Image size 1970x1876; CFP.
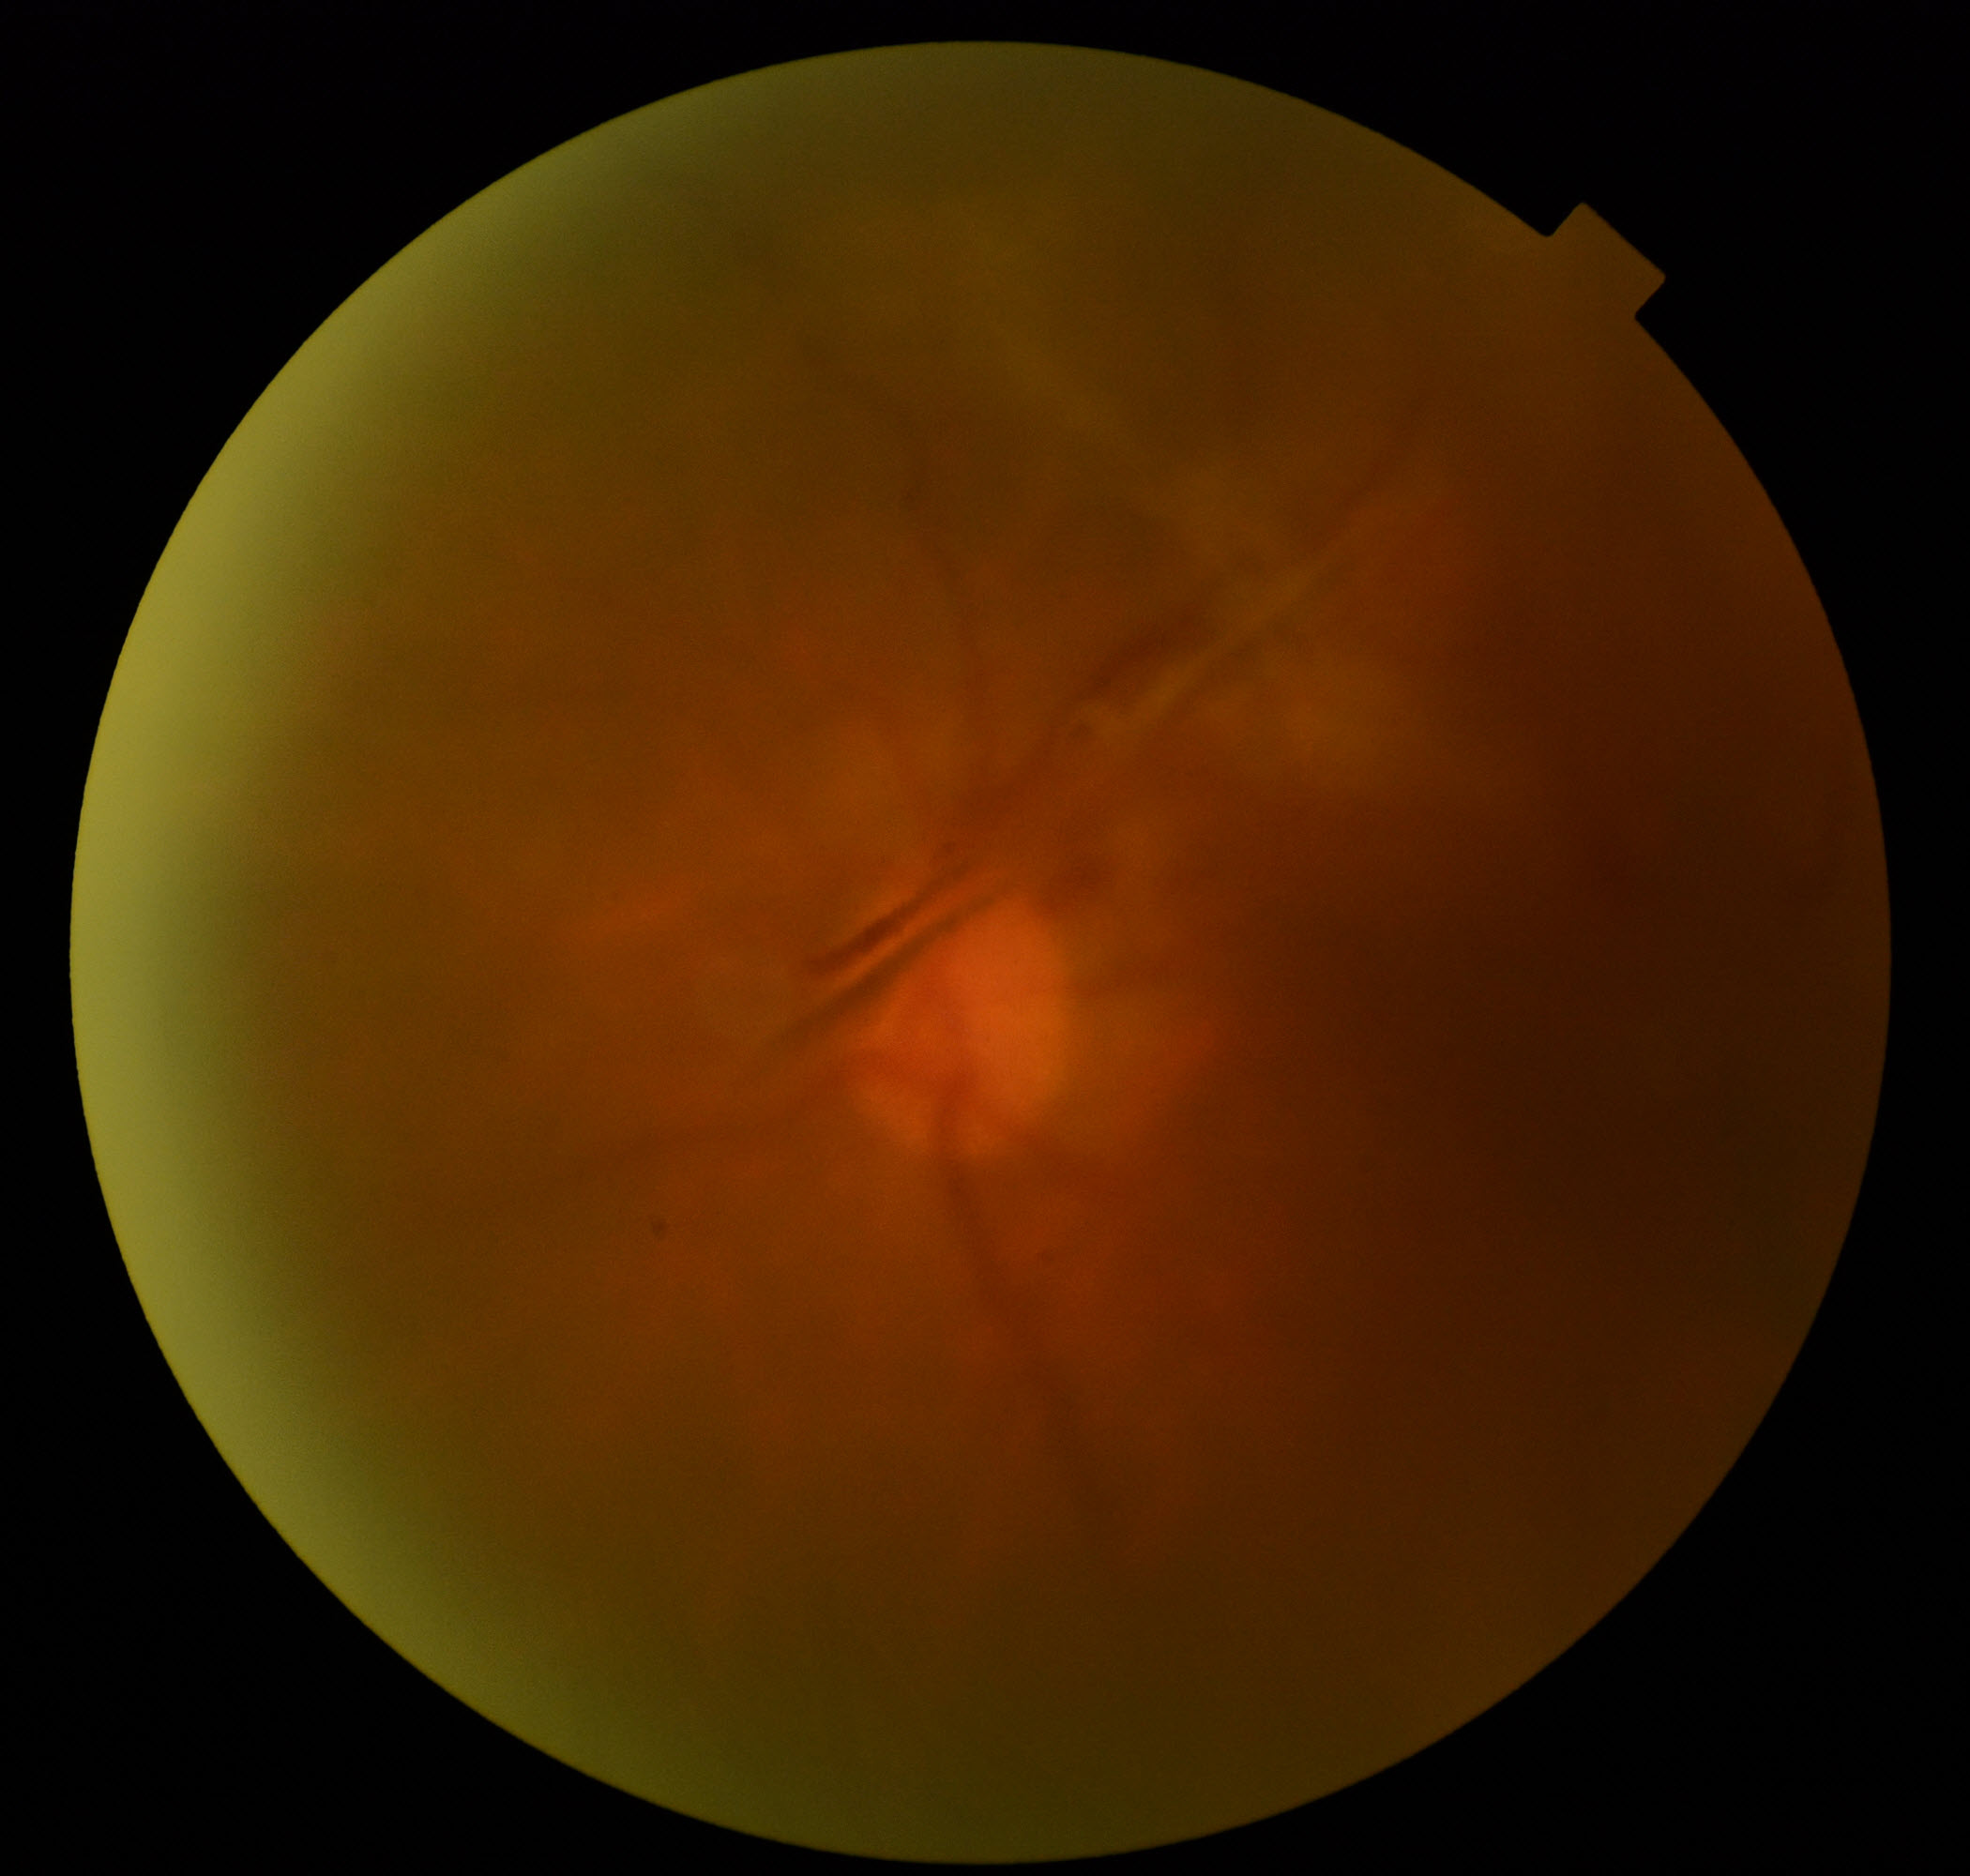
Quality: significantly degraded.
Proliferative retinopathy: features suspicious.